FOV: 45 degrees. DR severity per modified Davis staging: 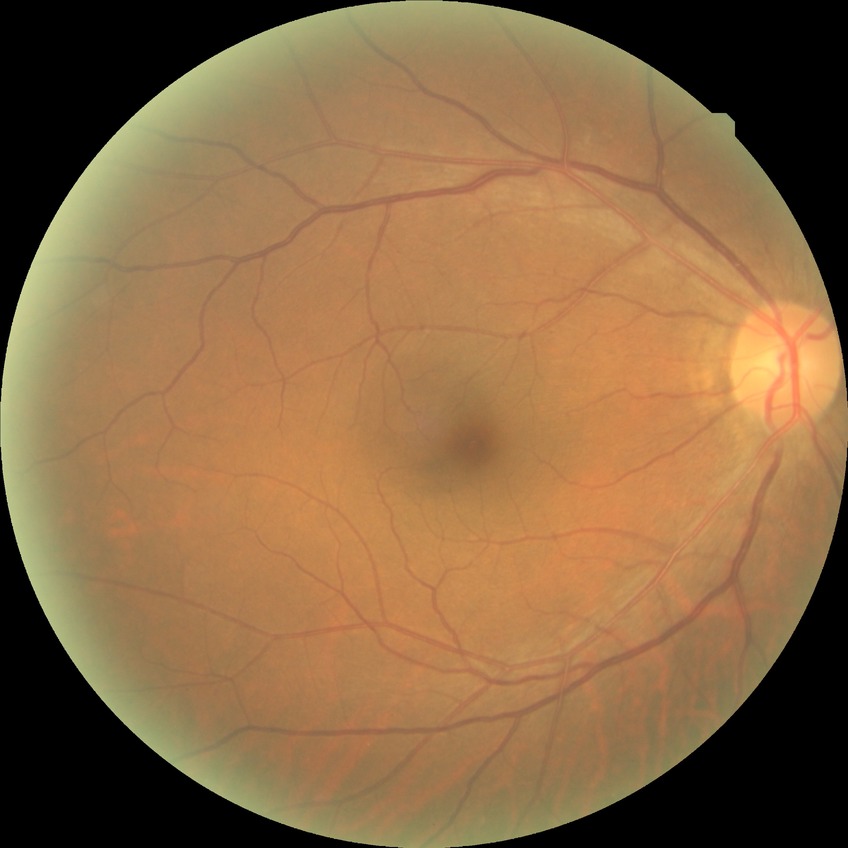 modified Davis grading: no diabetic retinopathy.